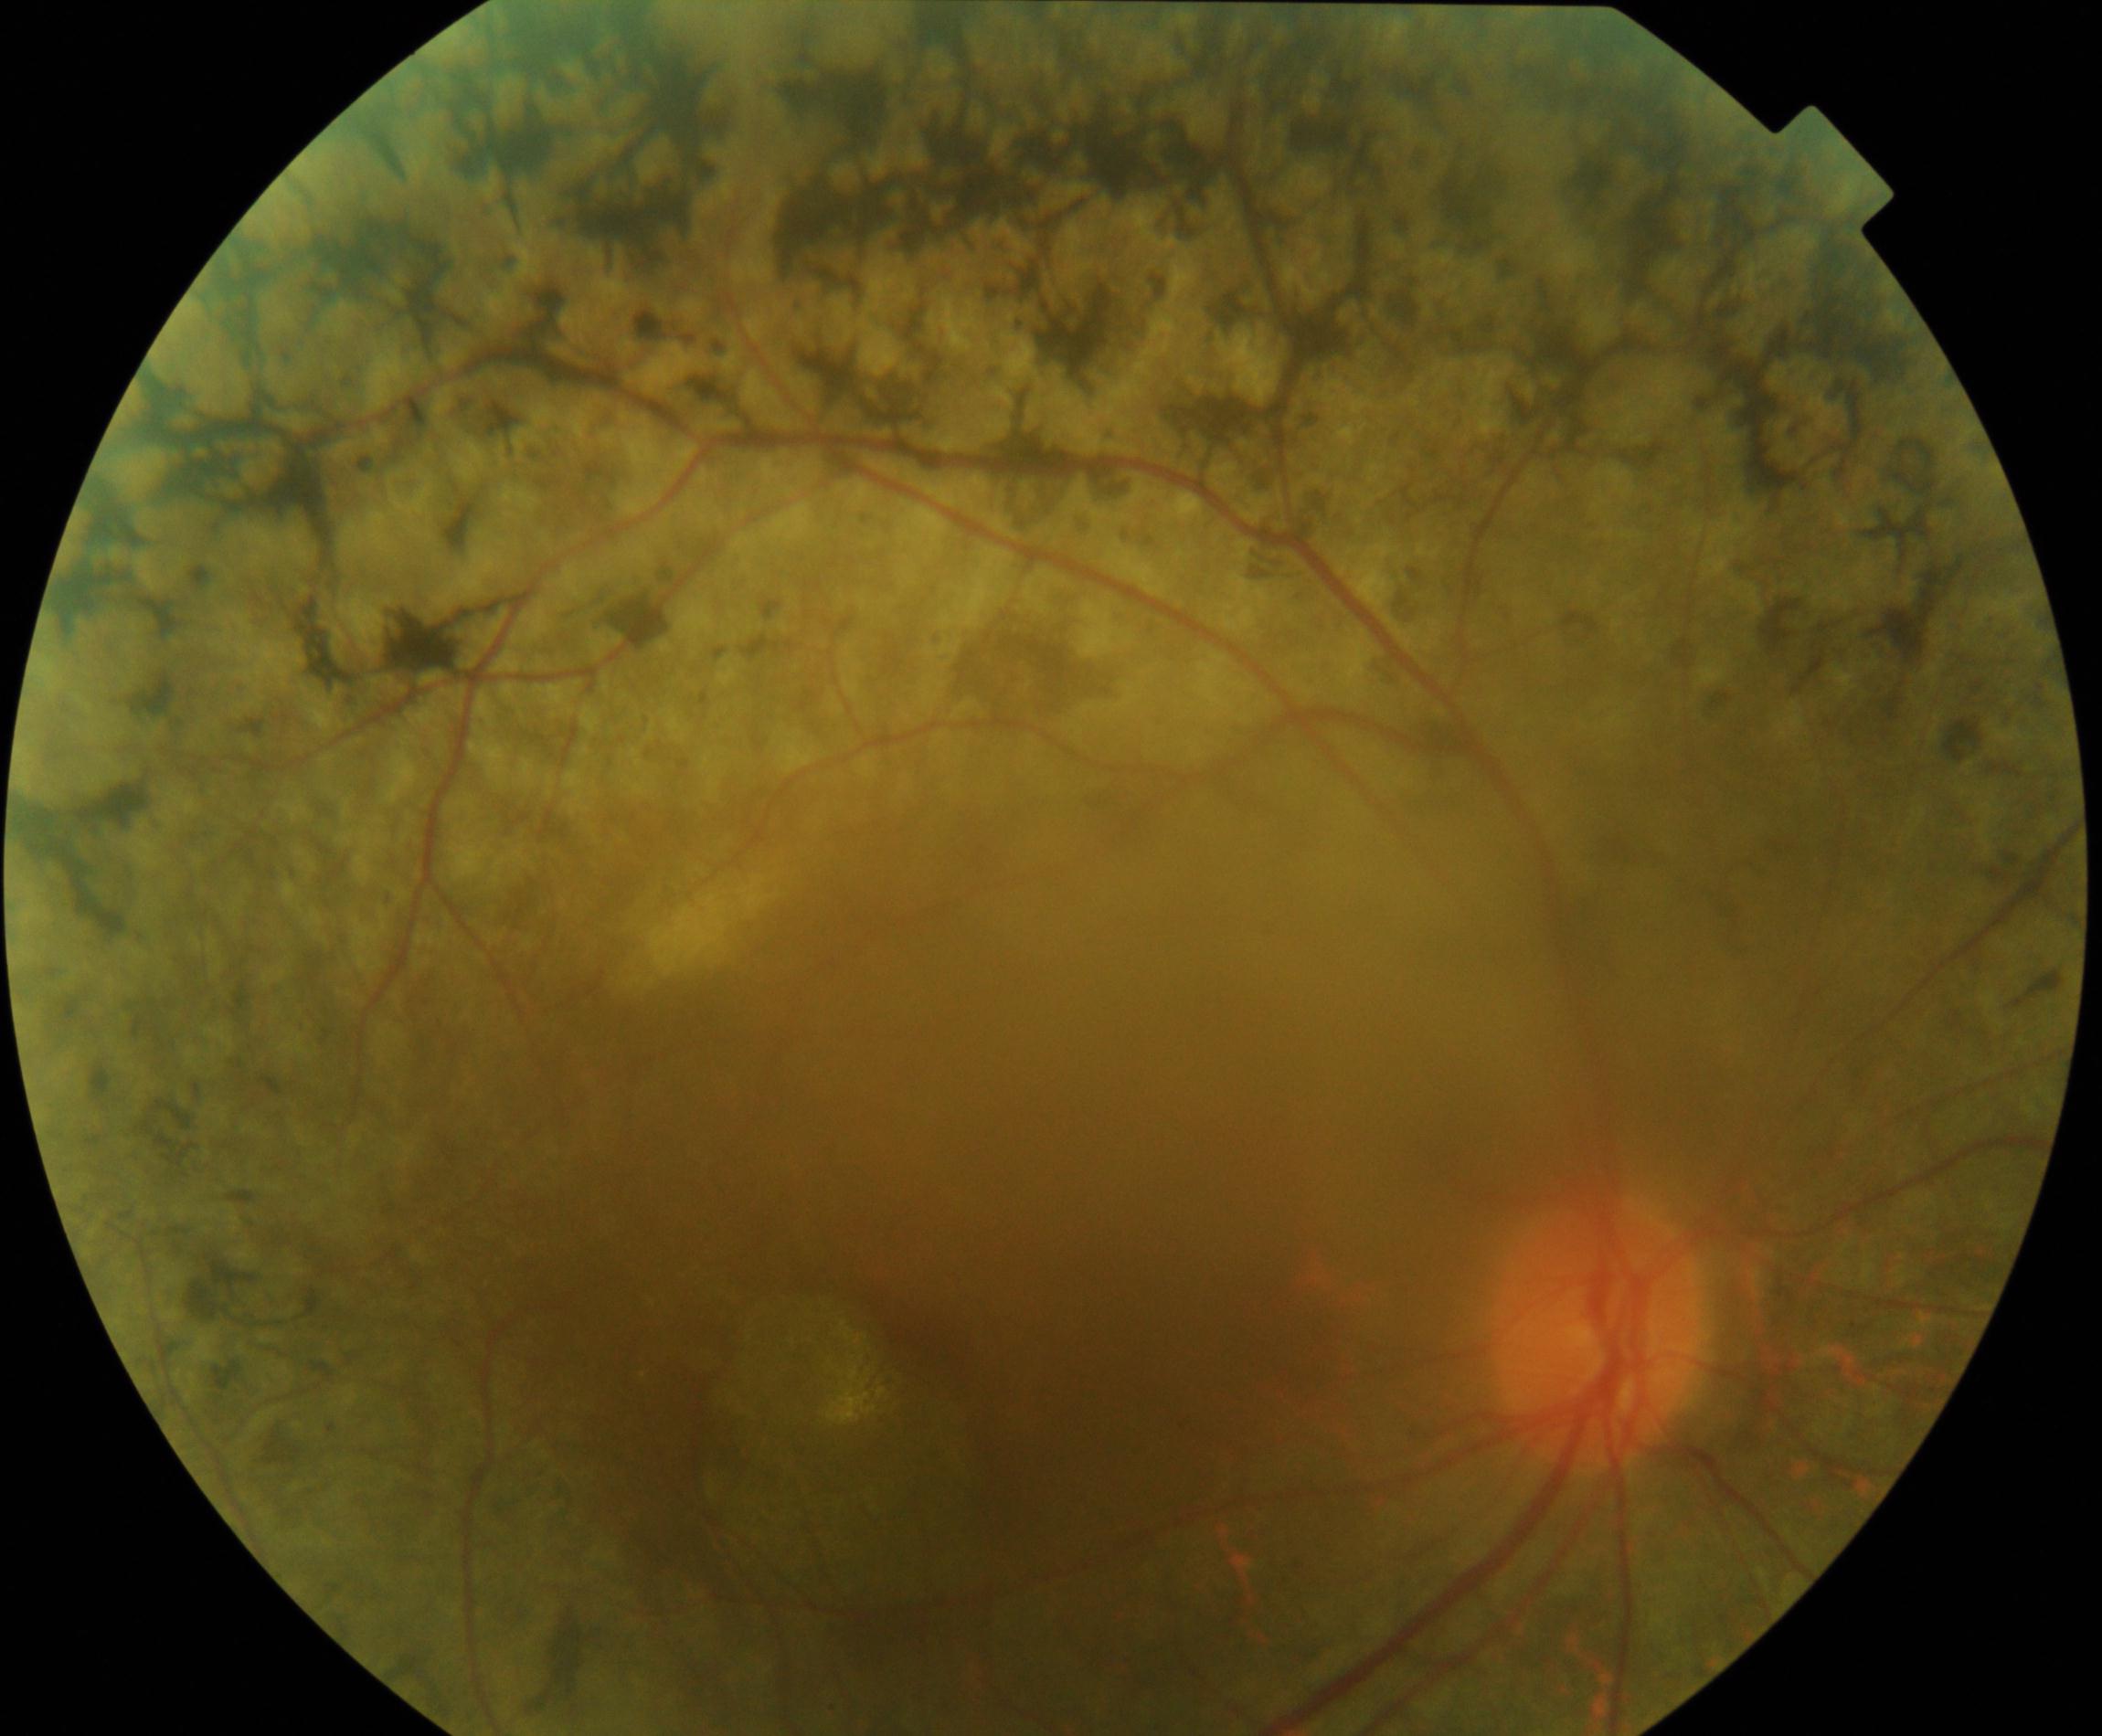 This fundus photograph shows retinitis pigmentosa.